Color fundus photograph; 1659x2212 — 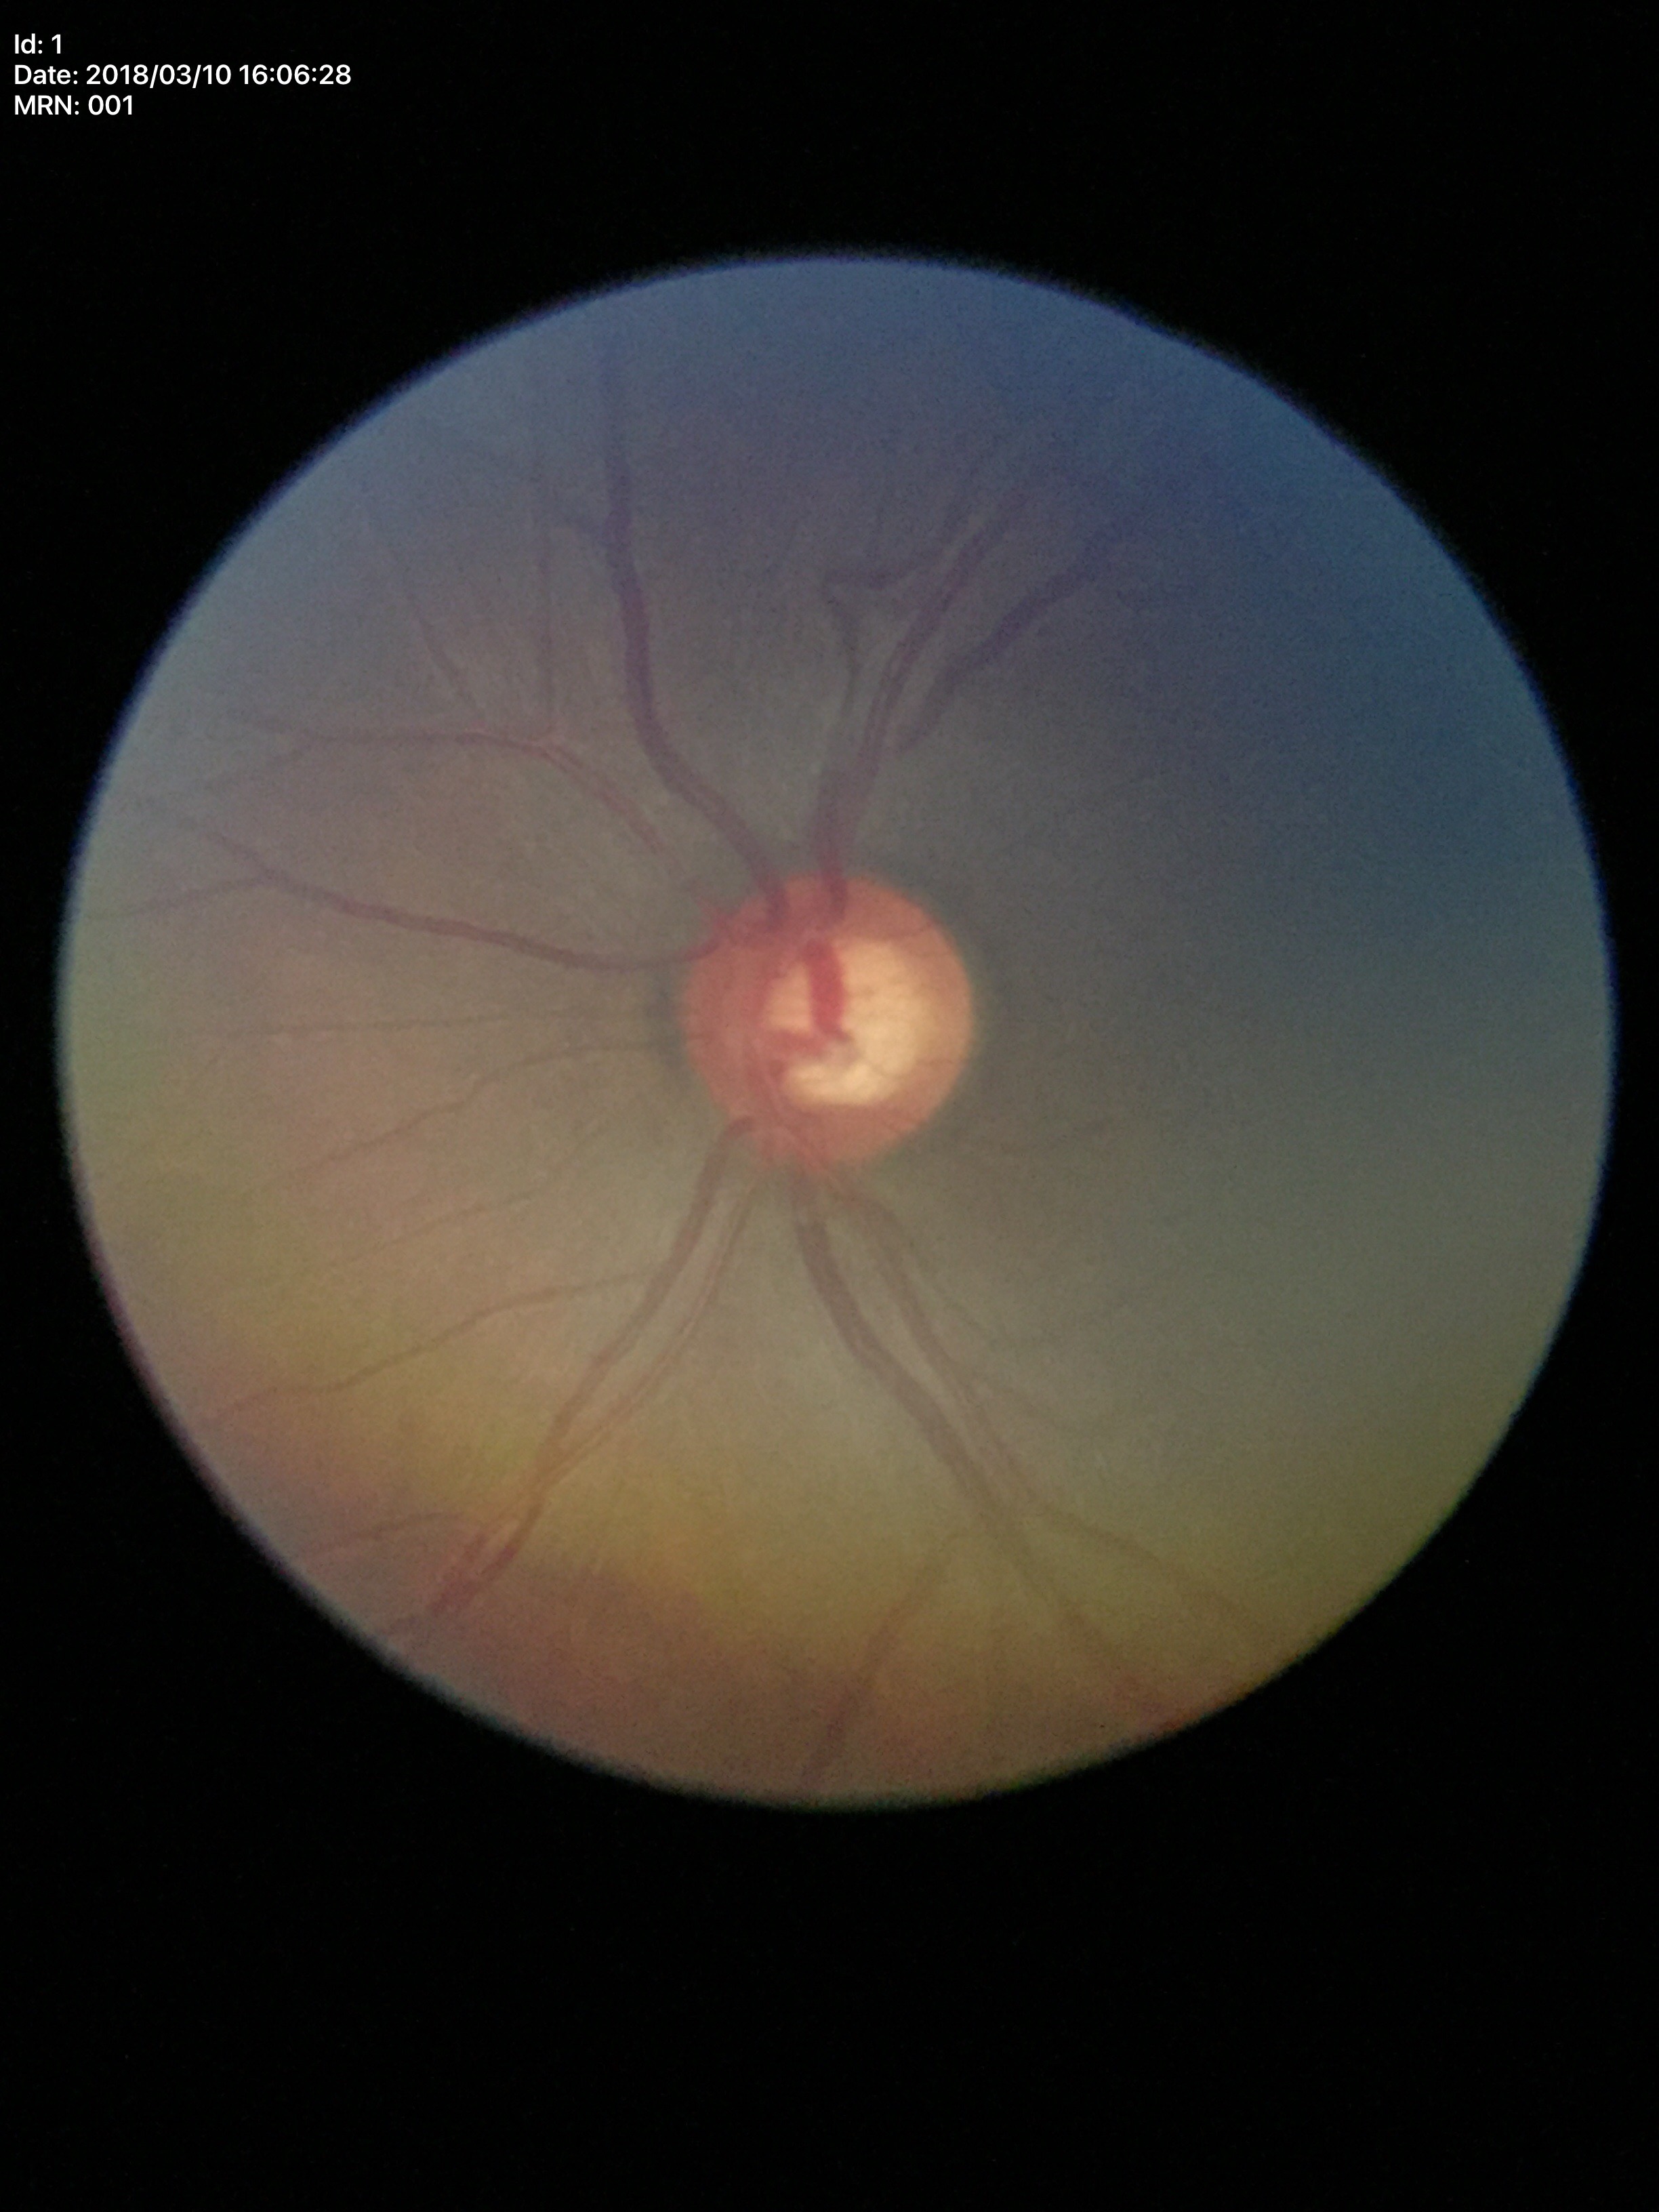

  glaucoma_decision: suspicious (3/5 graders called glaucoma suspect)
  vcdr: 0.61